45-degree field of view; color fundus image
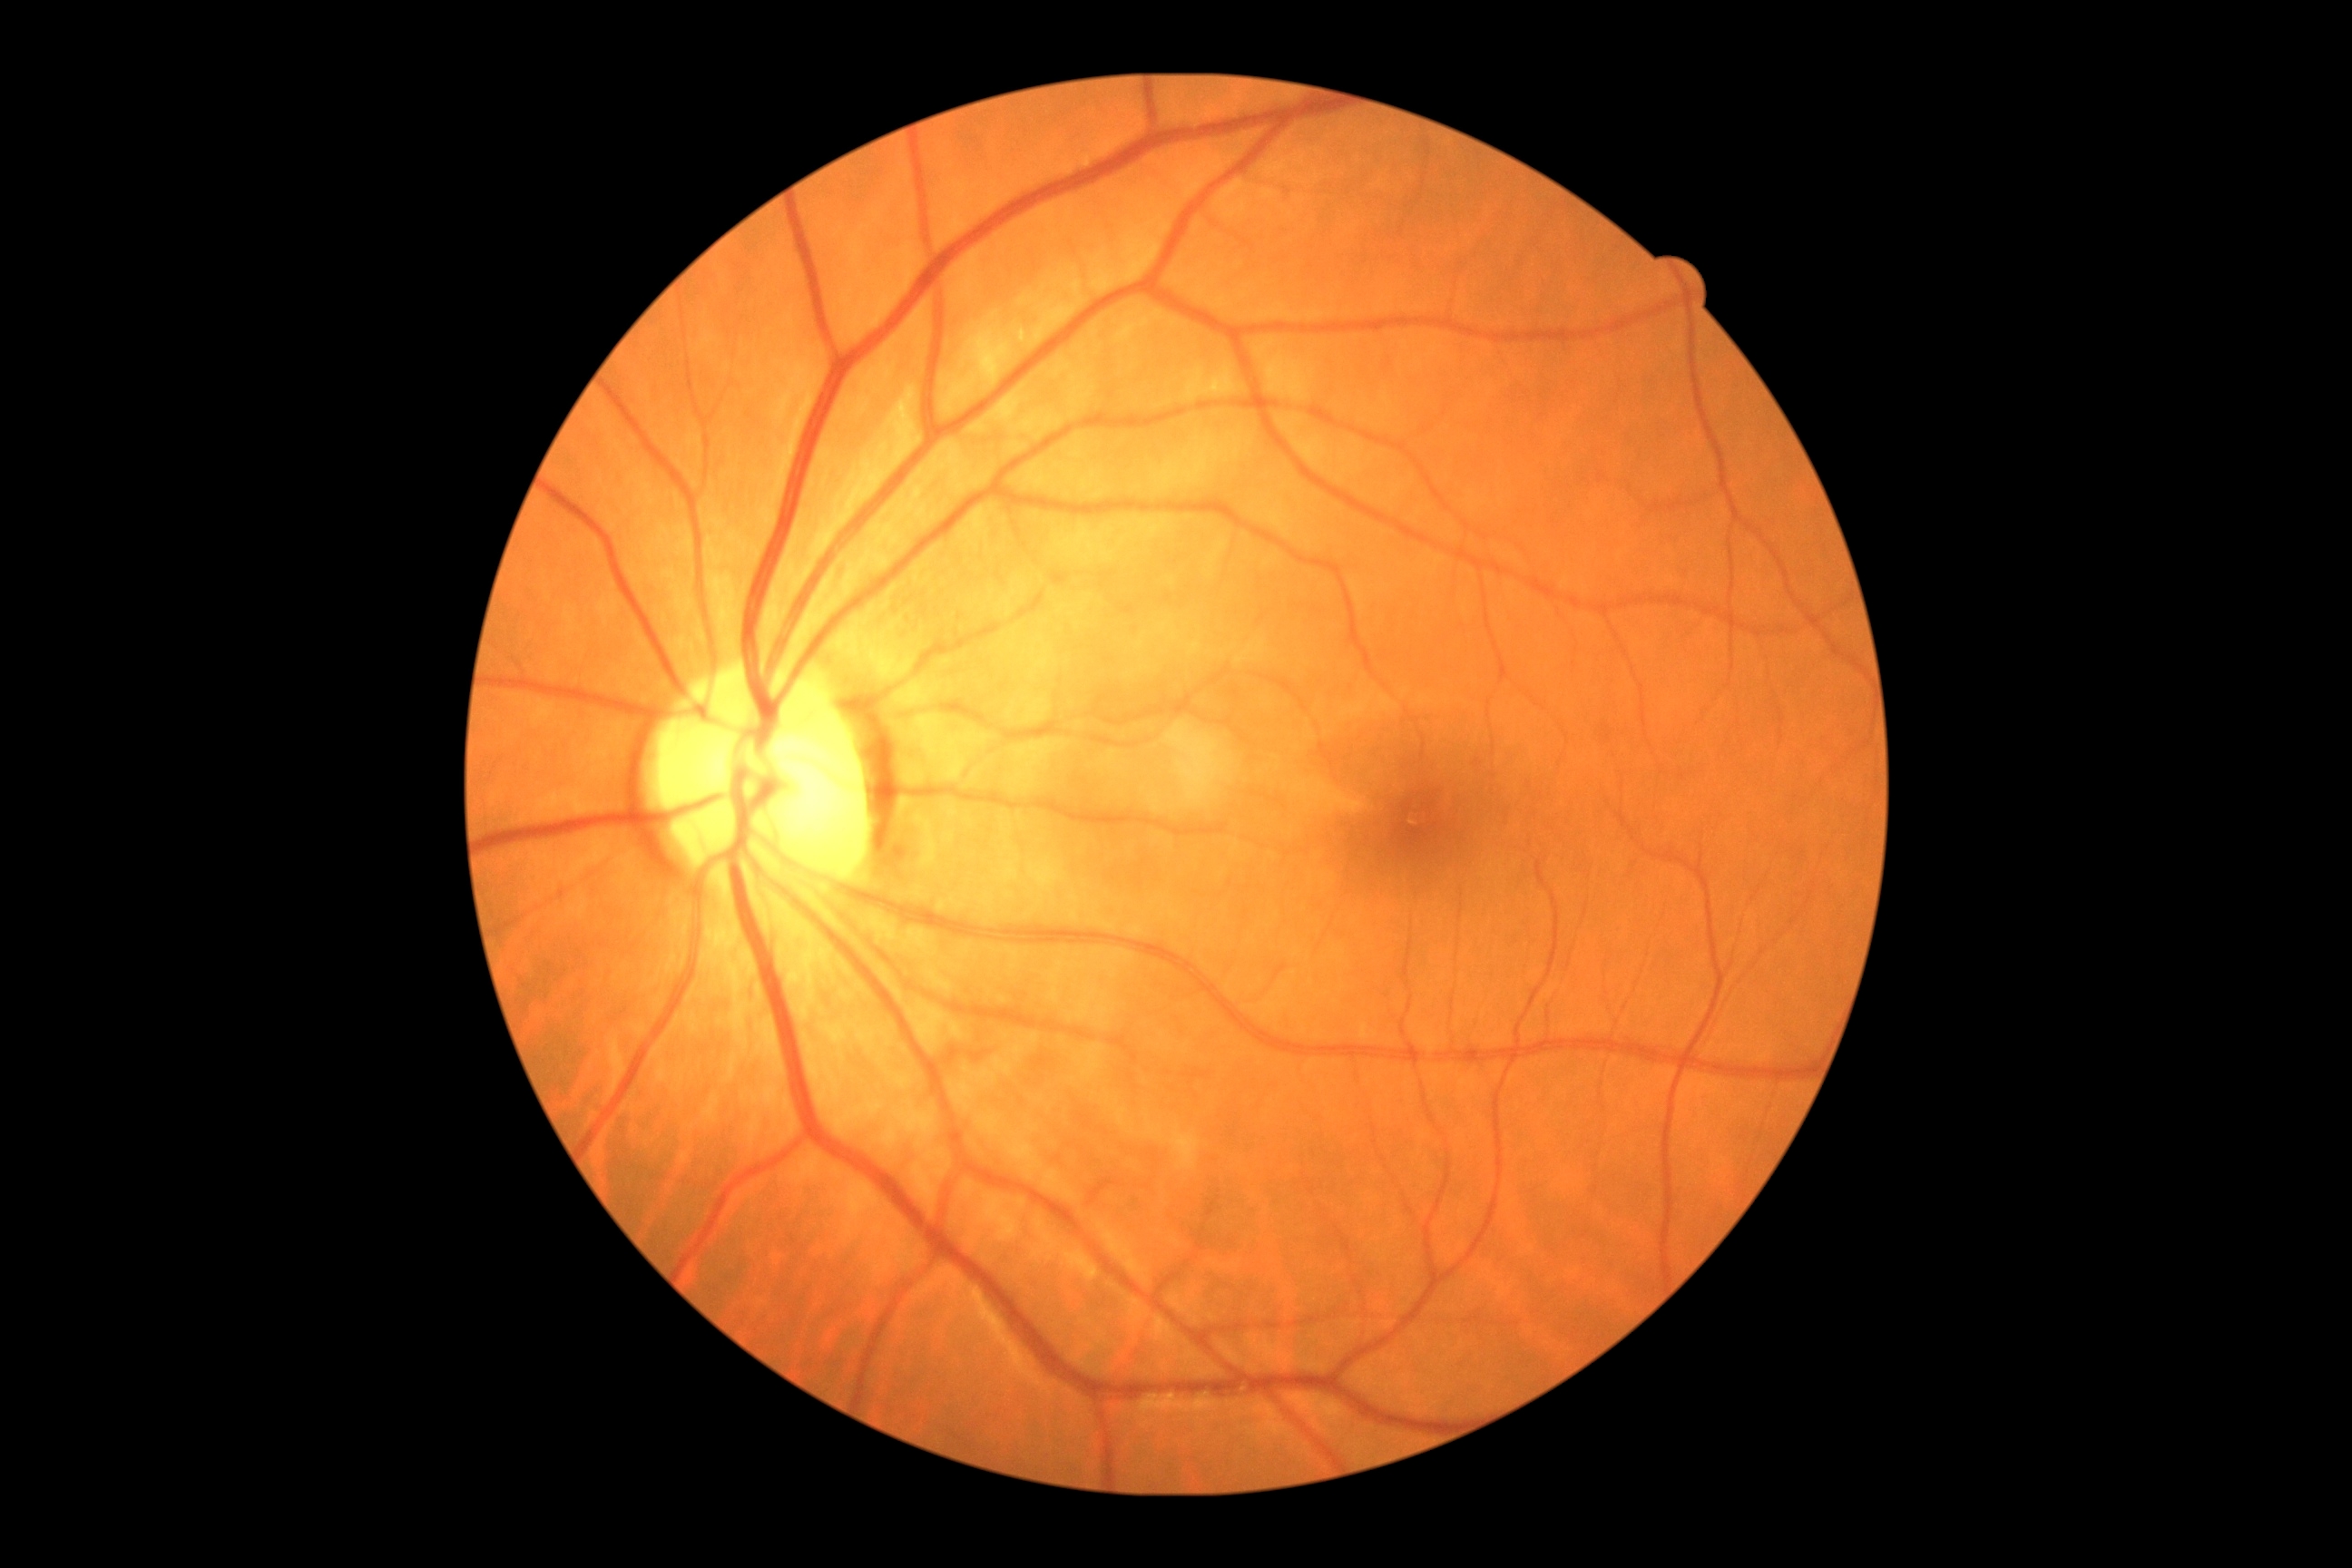
DR: grade 0 (no apparent retinopathy).